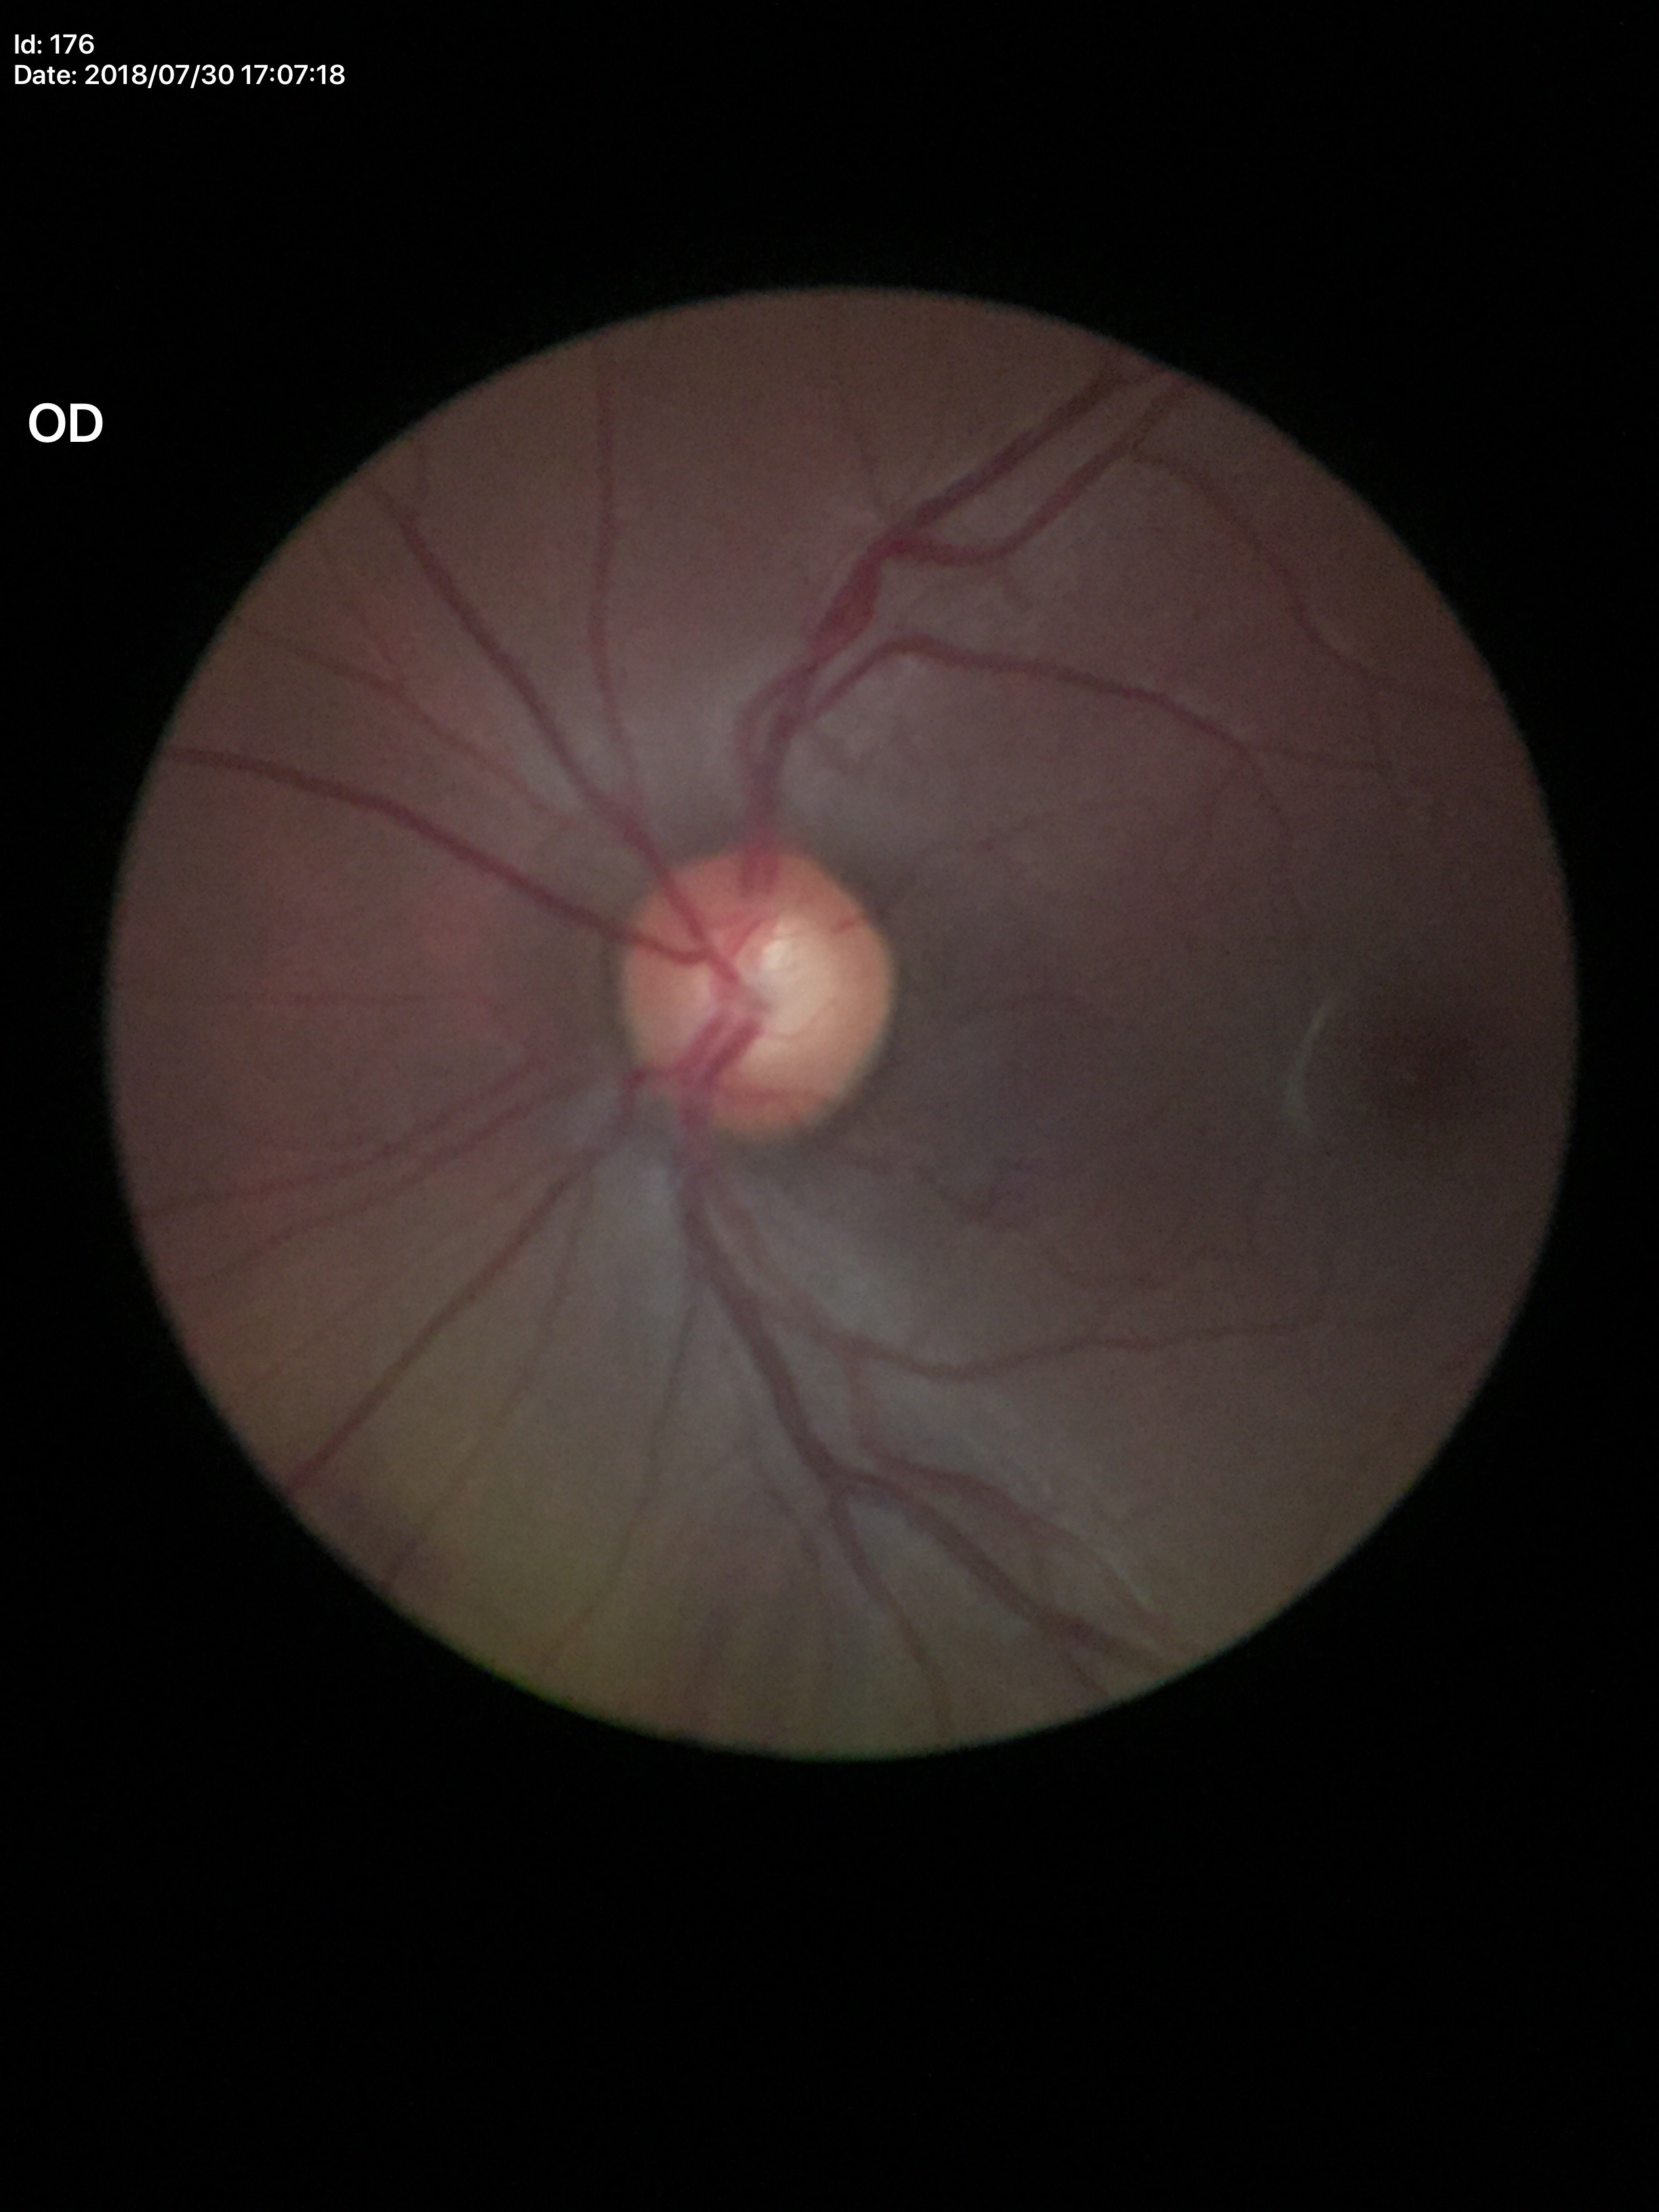 Glaucoma screening impression = no suspicious findings | VCDR = 0.57.